Wide-field fundus photograph of an infant. Captured with the Phoenix ICON (100° field of view): 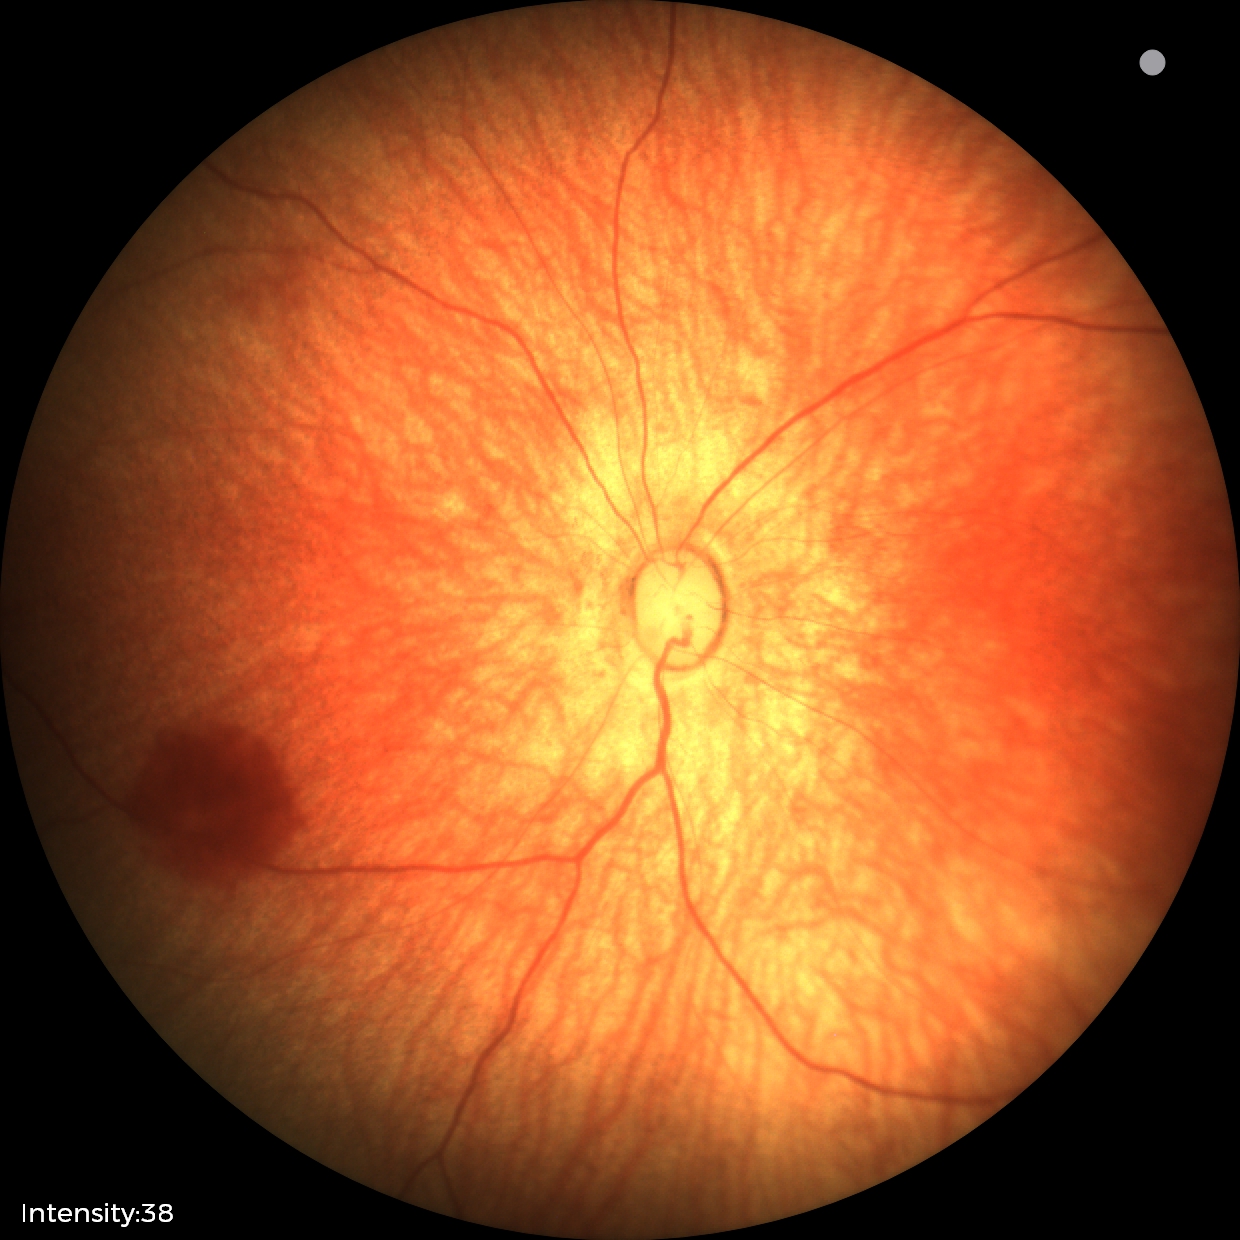
Q: What is the screening diagnosis?
A: physiological retinal finding